Wide-field contact fundus photograph of an infant
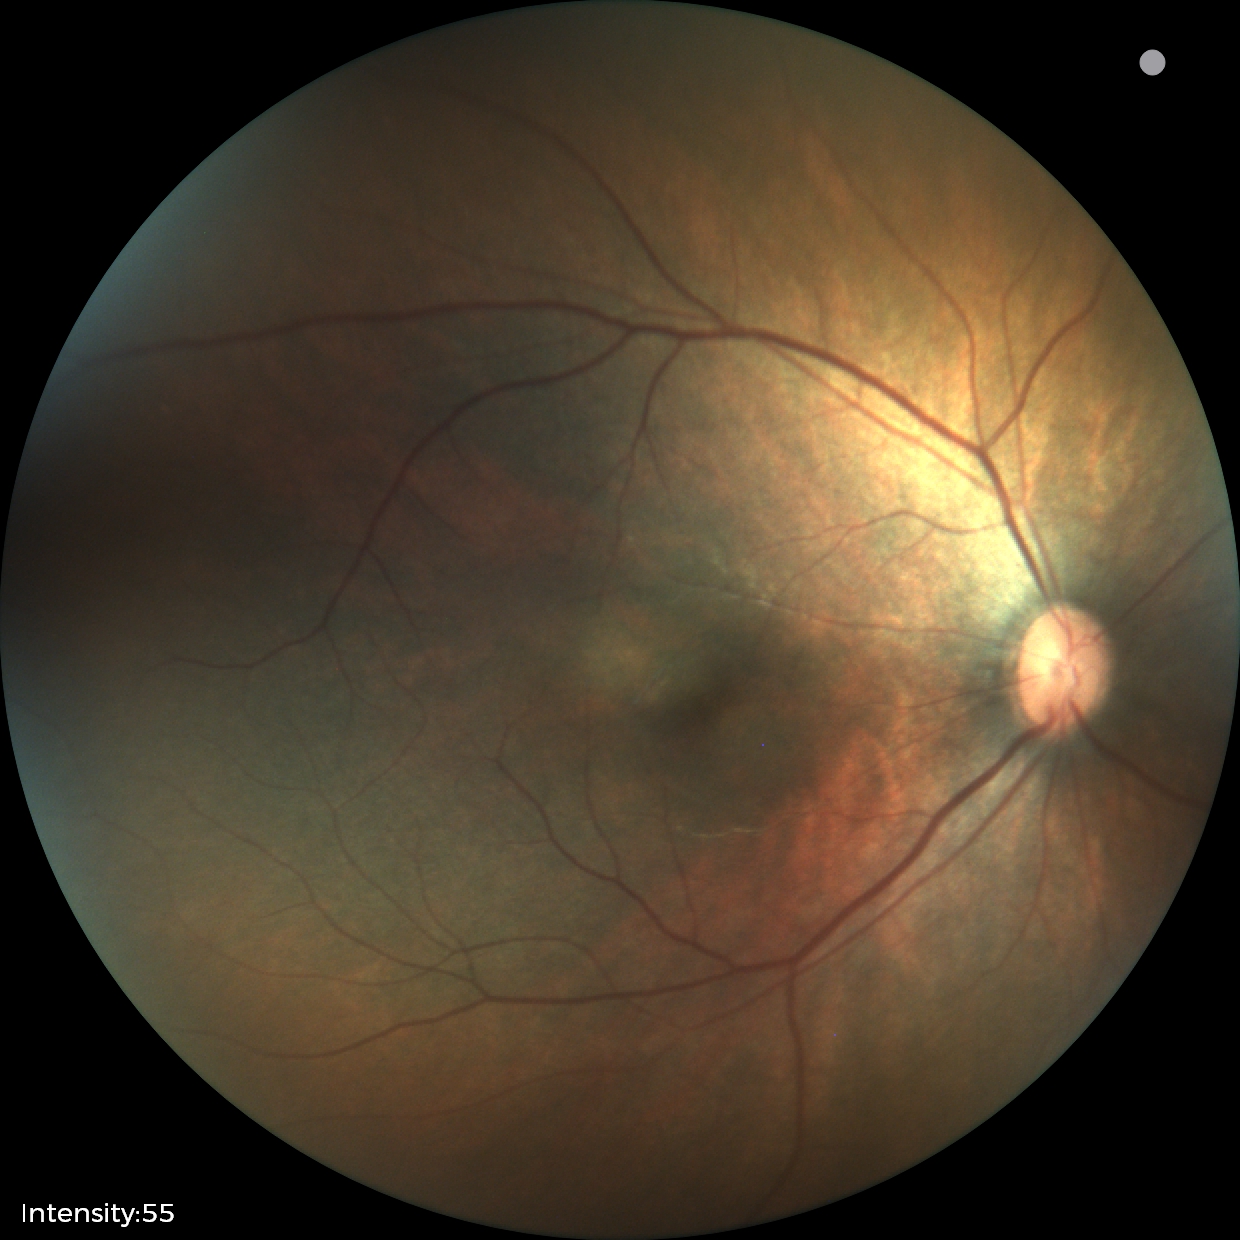 Normal screening examination.